Retinal fundus photograph
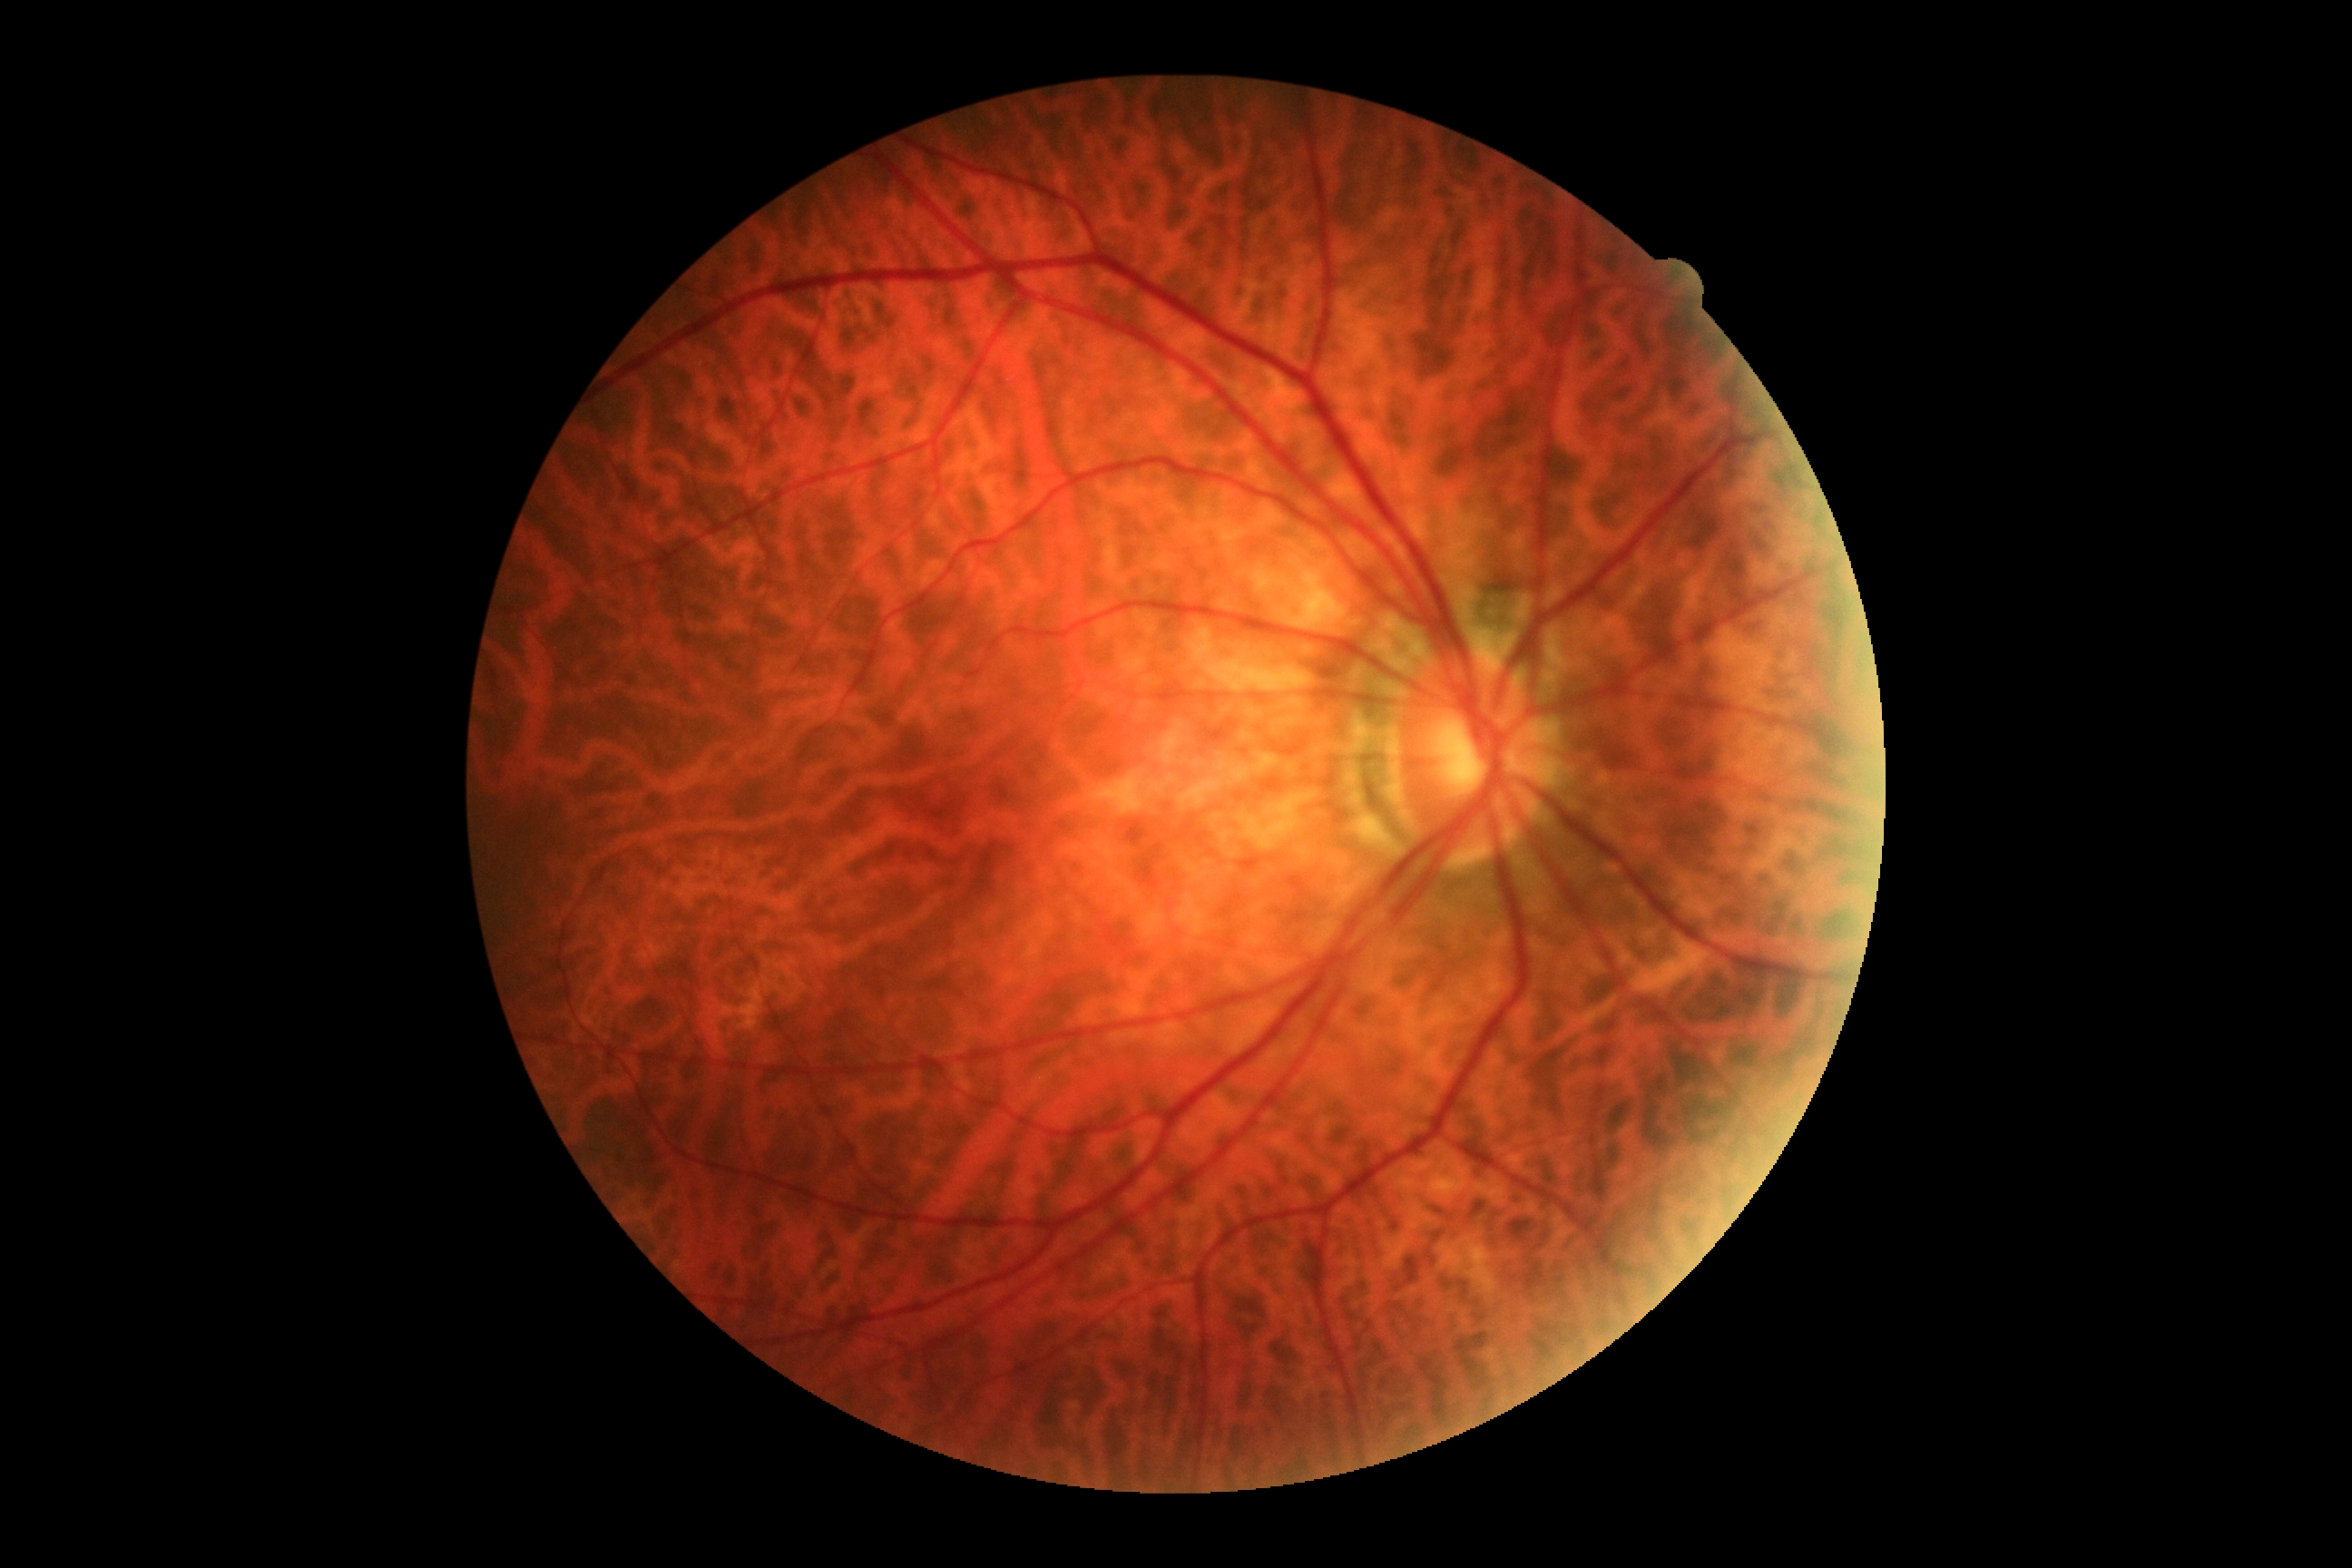 Retinopathy grade is no apparent retinopathy (0).
No signs of diabetic retinopathy.